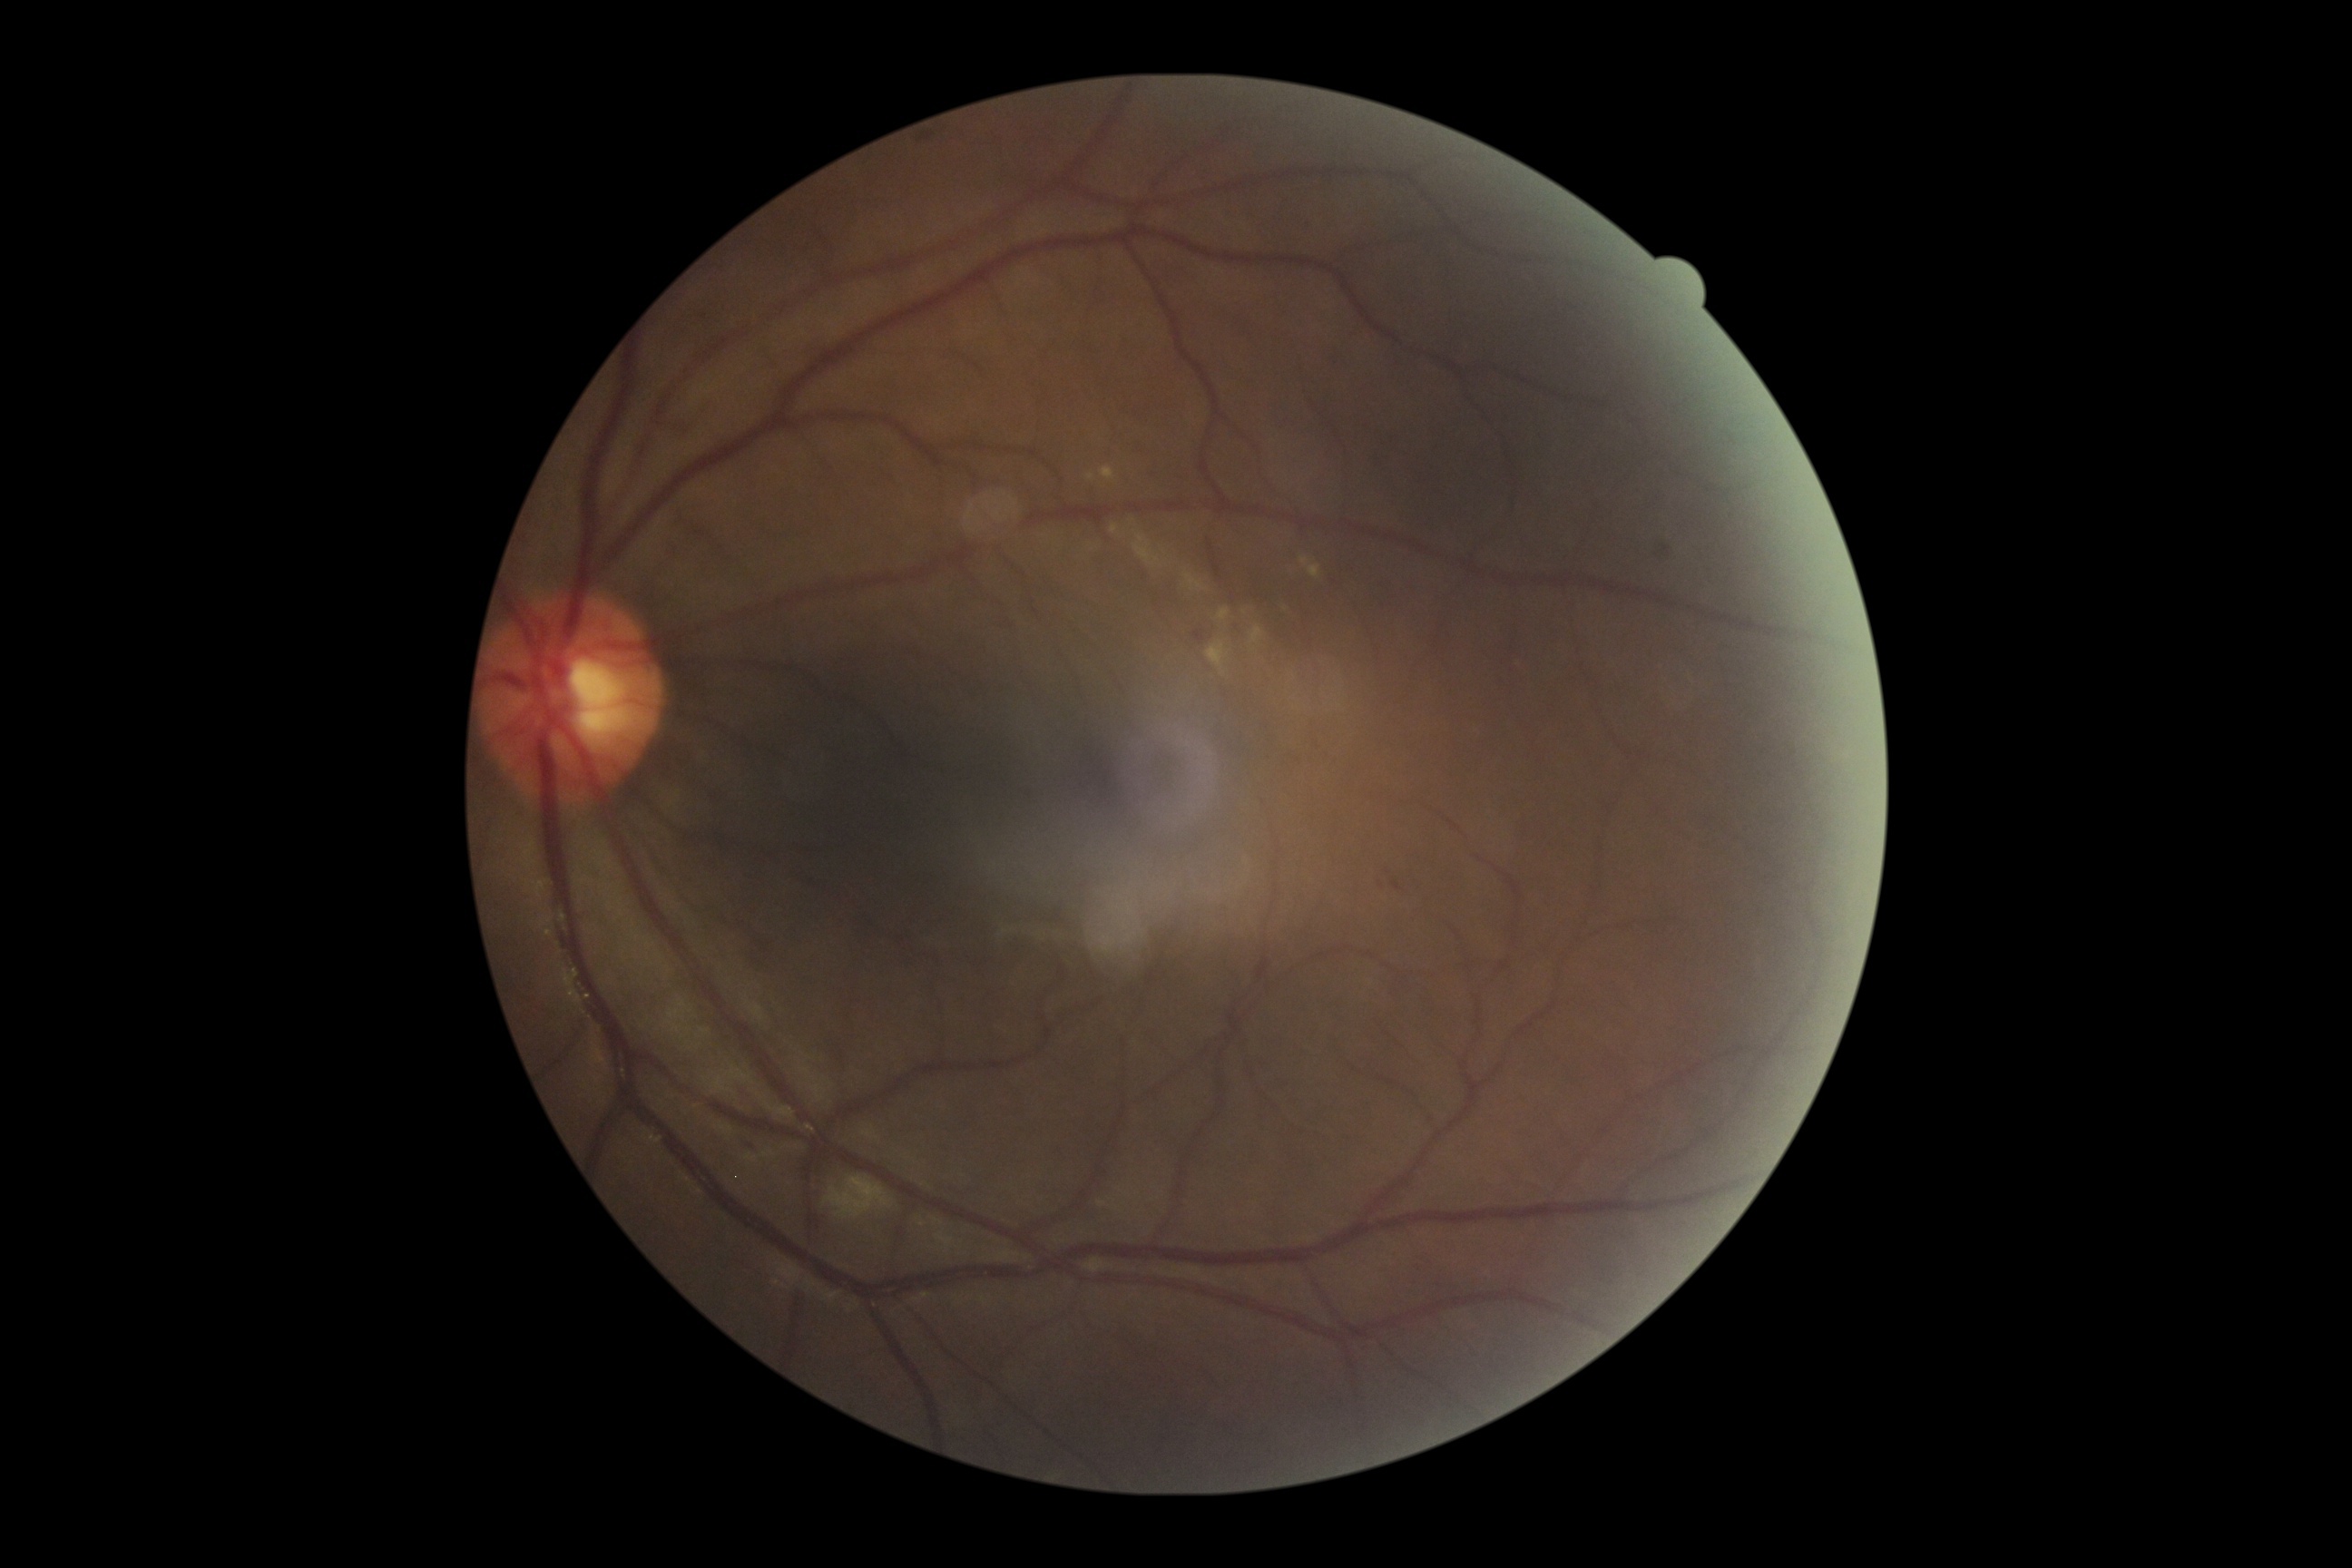
{"dr_grade": "2"}